Image size 2352x1568, 45° FOV
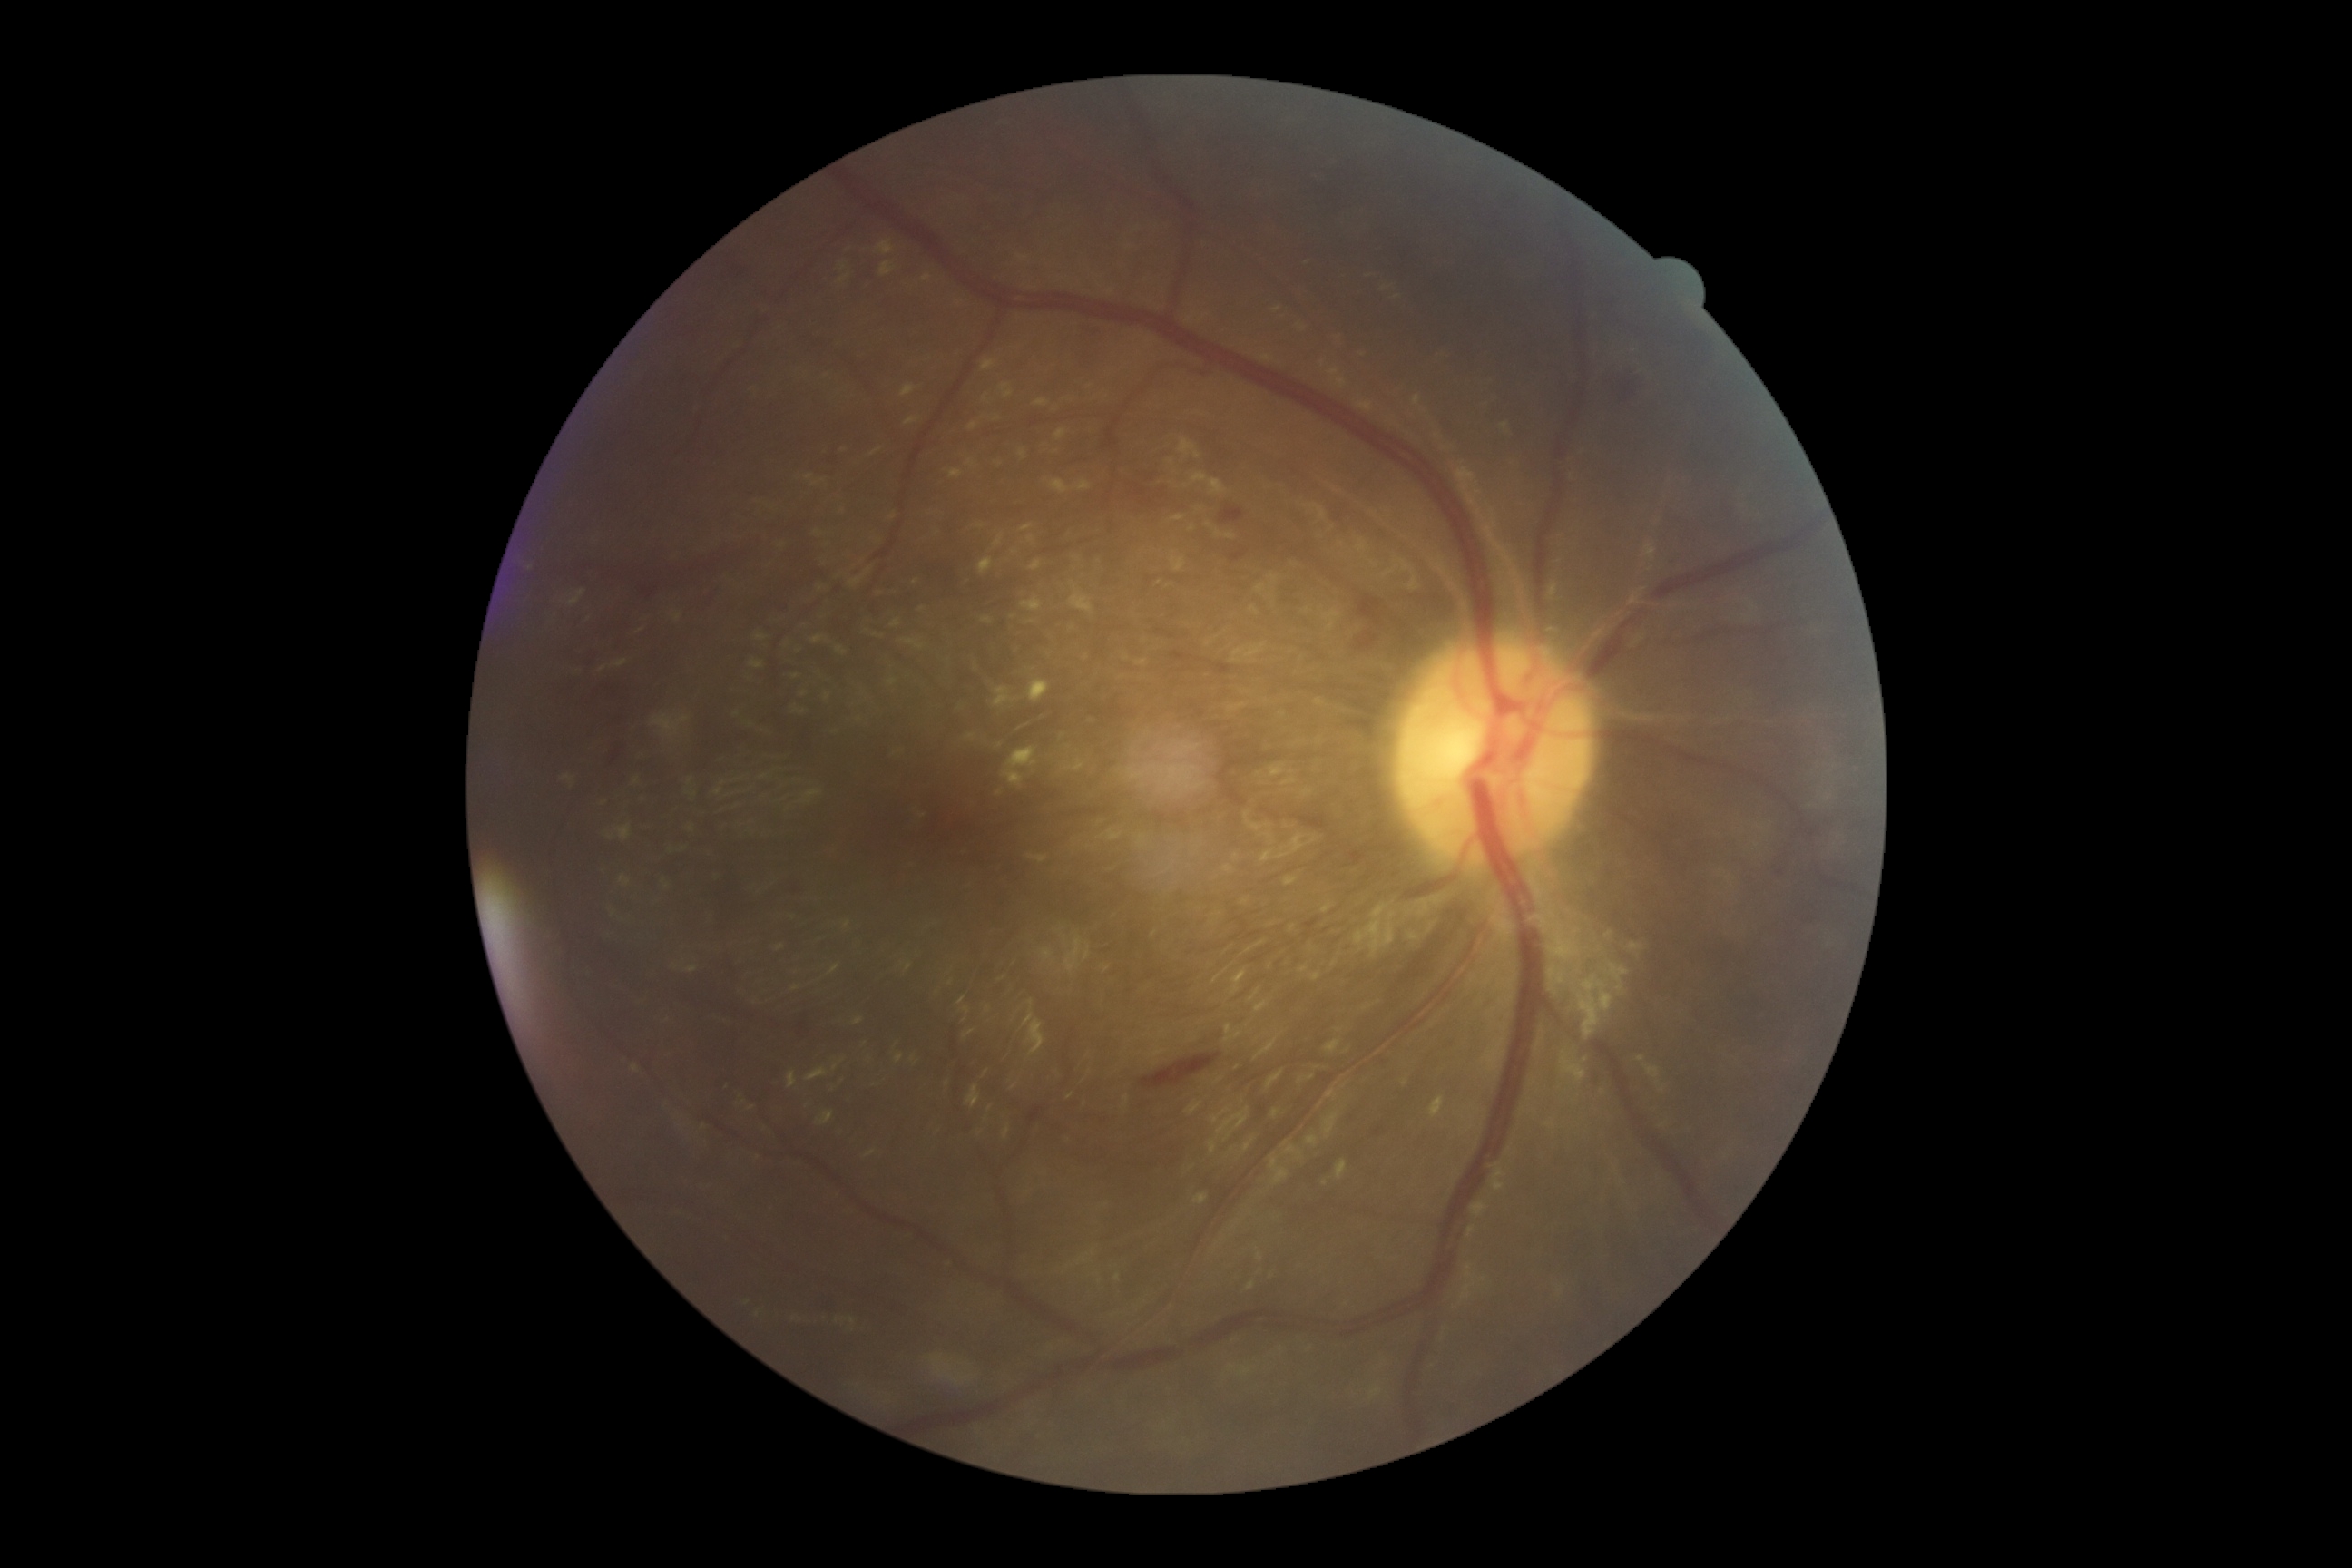

DR stage: 2/4.
EXs include those at <region>906, 418, 921, 426</region>, <region>1055, 429, 1066, 442</region>, <region>979, 558, 994, 576</region>, <region>1429, 1097, 1446, 1119</region>, <region>1028, 680, 1050, 703</region>, <region>838, 275, 850, 284</region>, <region>966, 458, 975, 467</region>, <region>1077, 480, 1092, 491</region>, <region>879, 262, 896, 277</region>, <region>1021, 598, 1043, 612</region>, <region>981, 360, 997, 371</region>, <region>1035, 400, 1050, 406</region>.
Additional small EXs near pt(998, 419), pt(1000, 794), pt(1032, 621), pt(973, 427).